130° field of view (Clarity RetCam 3); infant wide-field fundus photograph.
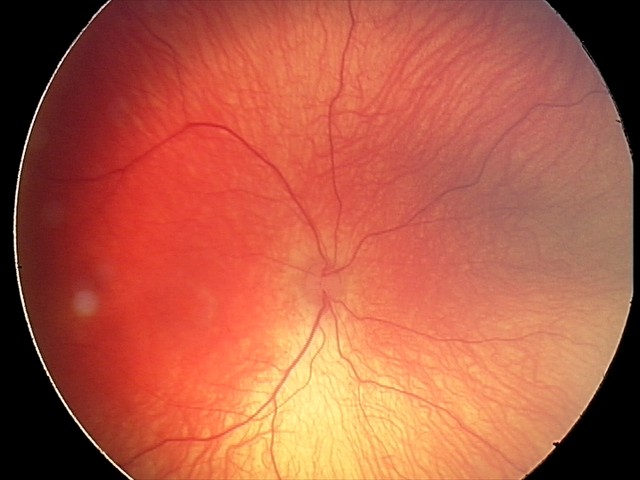 Plus disease: absent
screening diagnosis: ROP stage 1